Modified Davis classification: 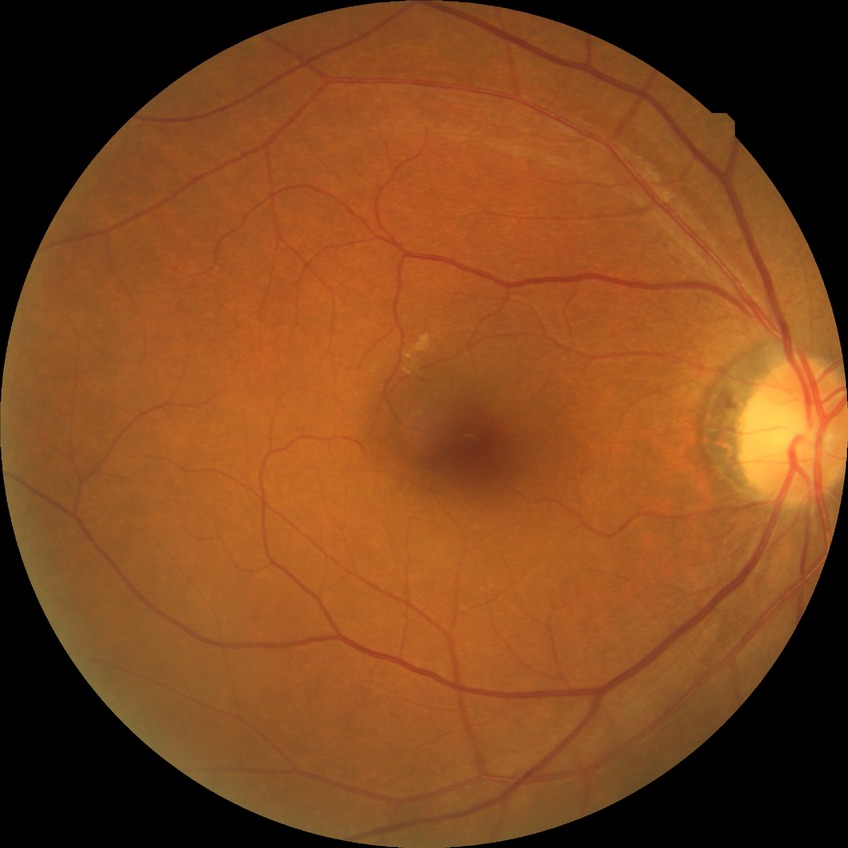 diabetic retinopathy (DR): no diabetic retinopathy (NDR).